FOV: 45 degrees. 1932x1916px. CFP — 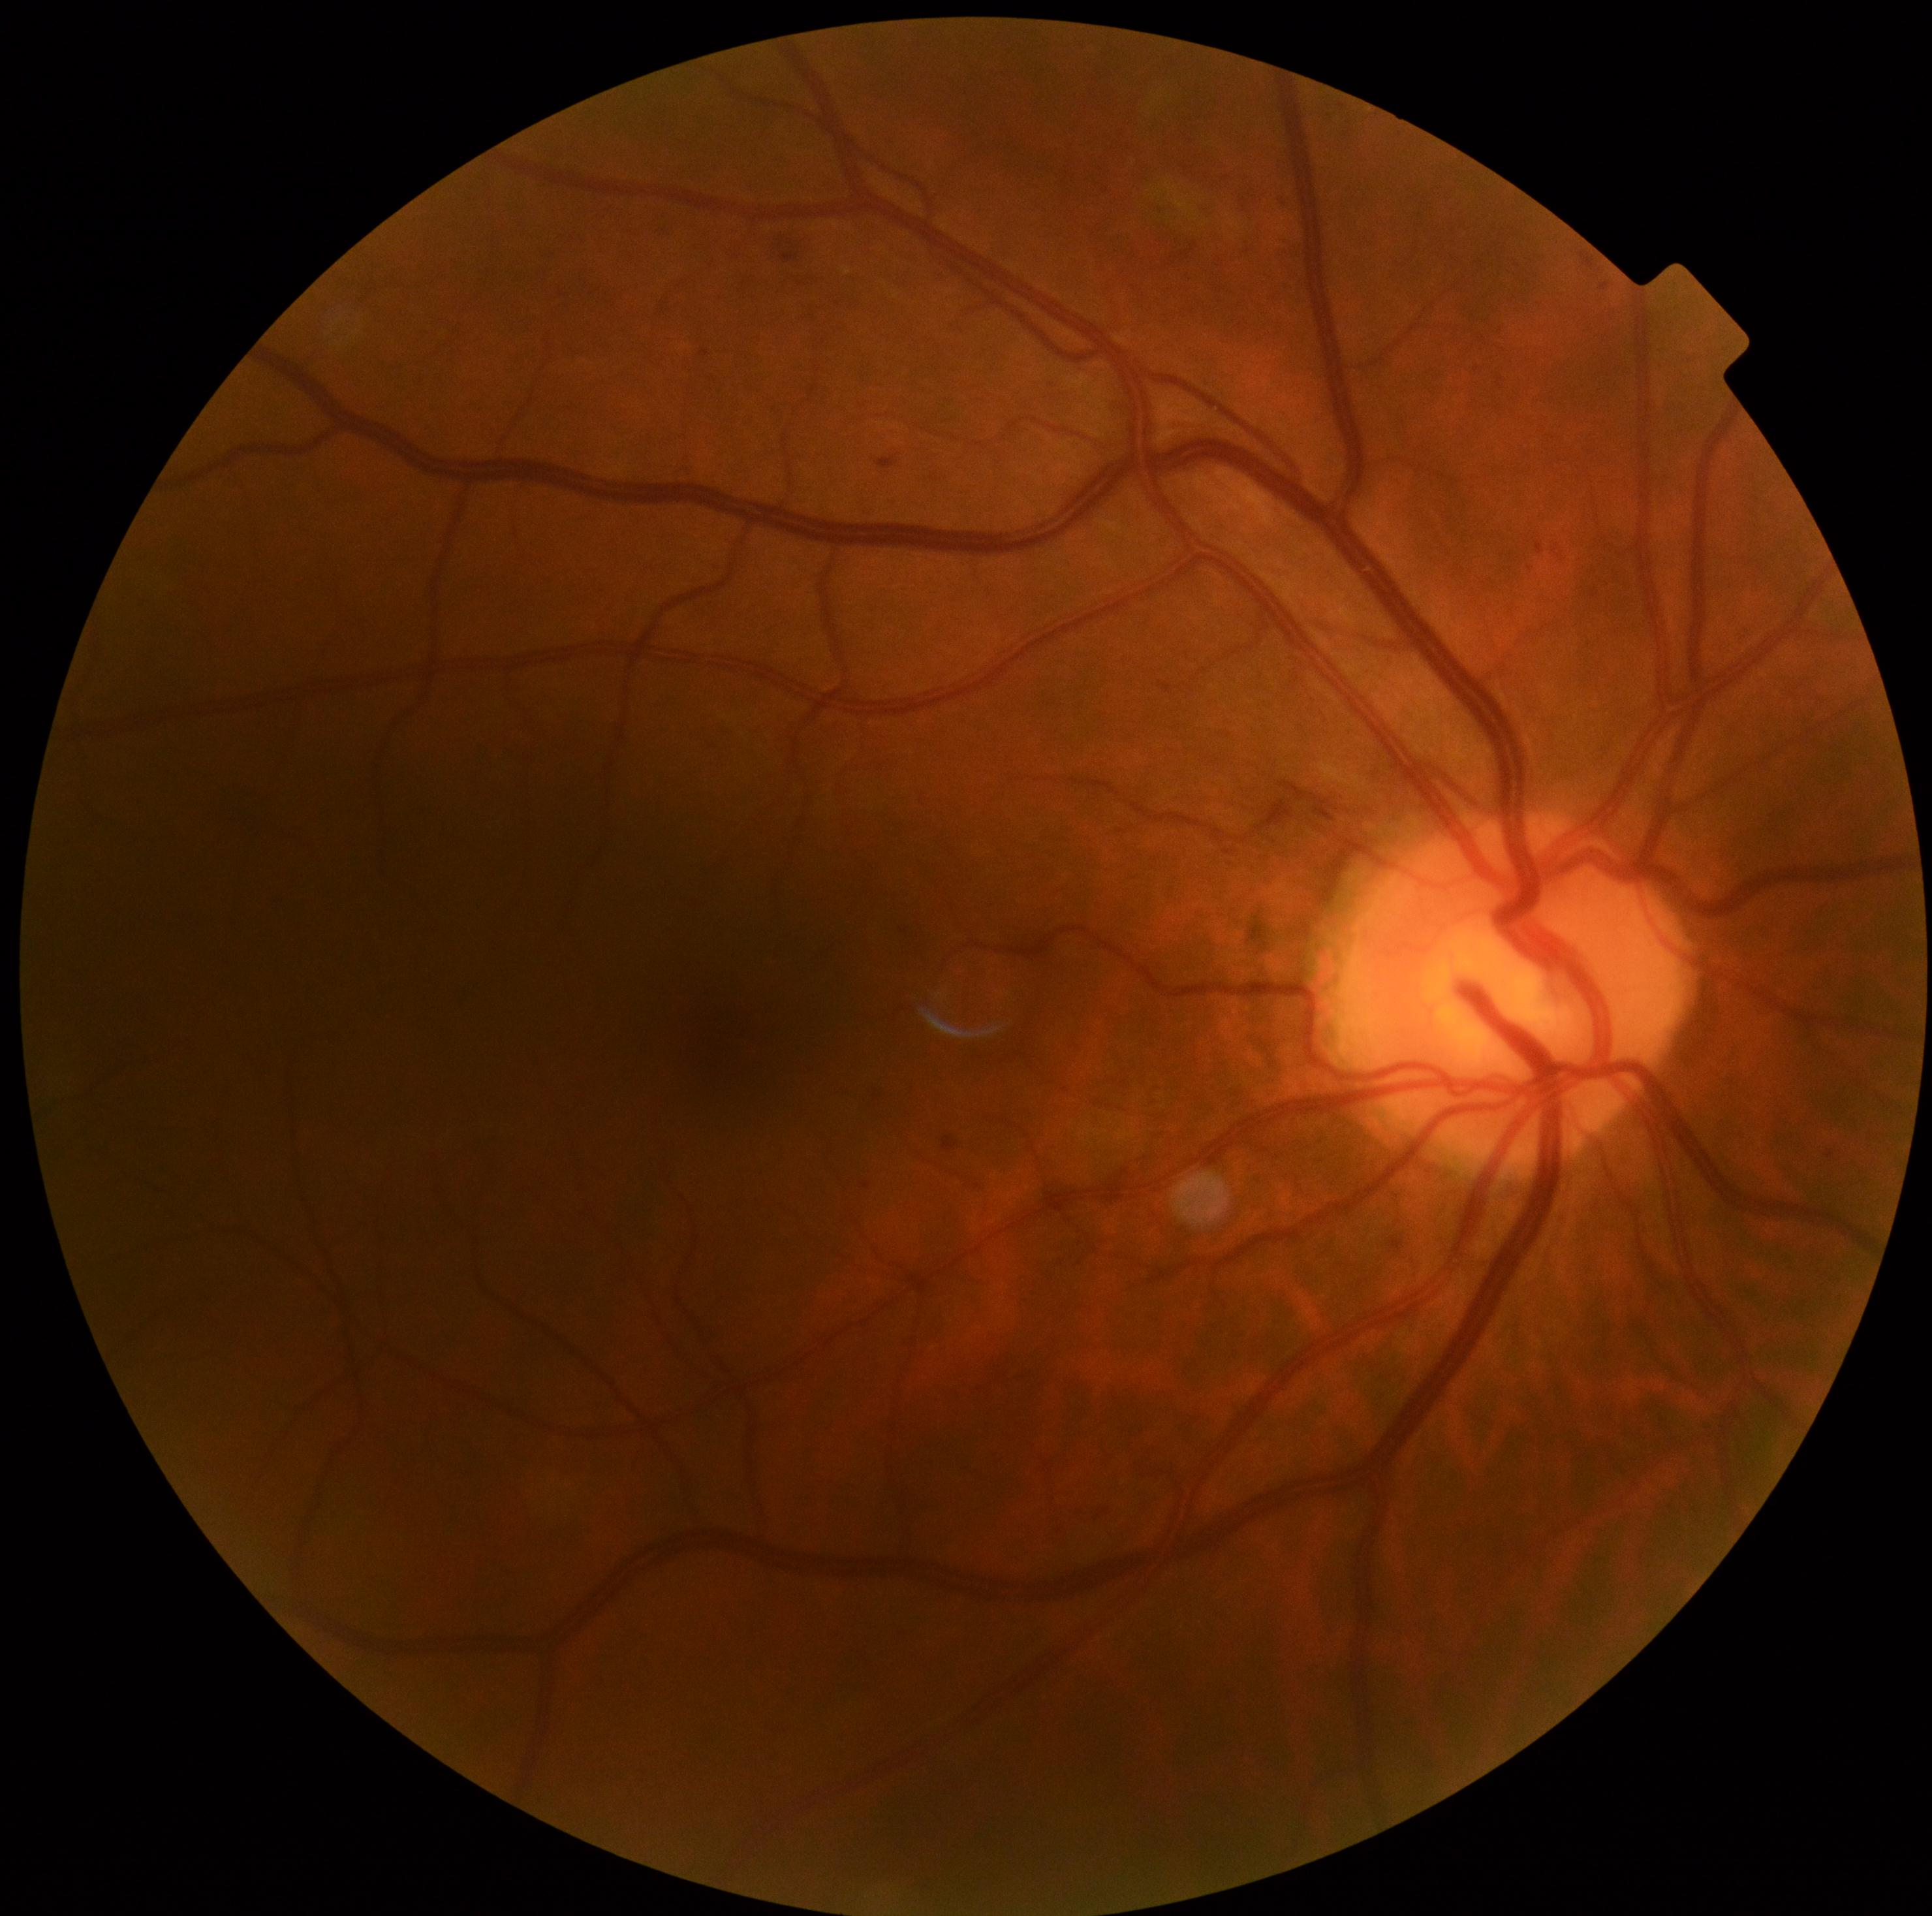

Diabetic retinopathy (DR) is grade 2 (moderate NPDR).